45-degree field of view
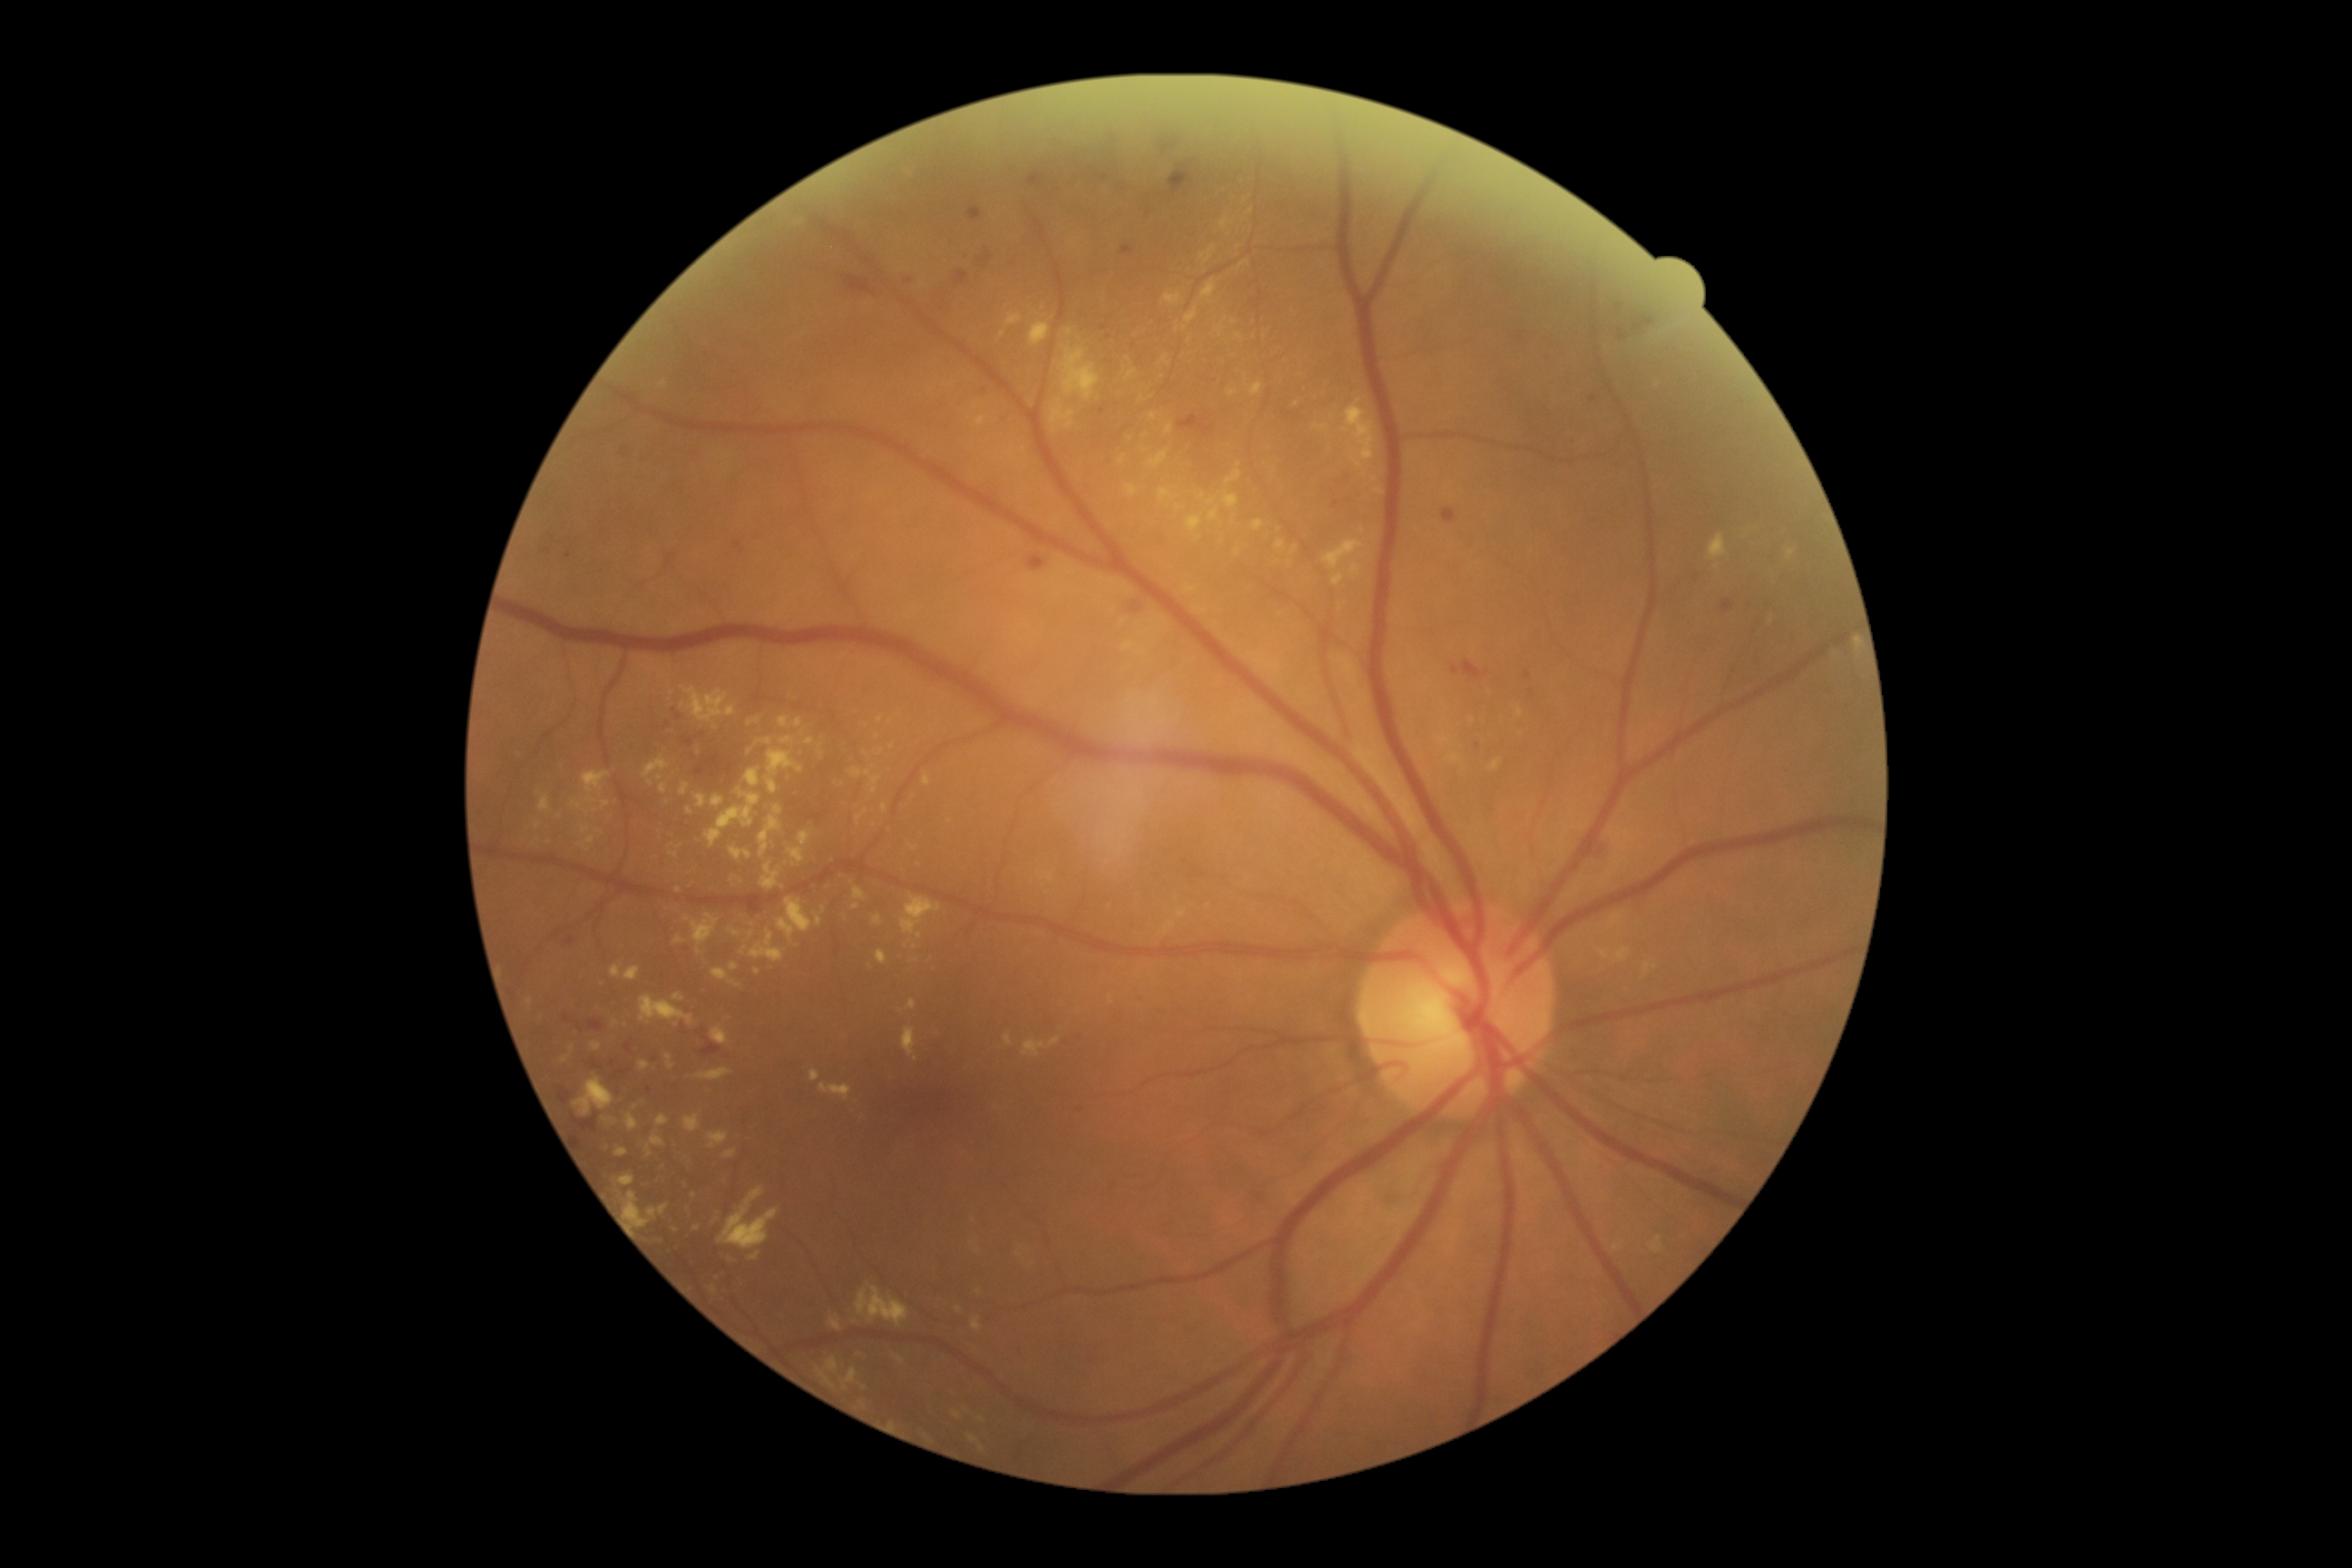
Diabetic retinopathy (DR): grade 2 (moderate NPDR)
A subset of detected lesions:
hard exudates (EXs) (subset): [540, 796, 551, 812] | [614, 1175, 636, 1186] | [774, 807, 783, 816] | [1061, 348, 1101, 400] | [779, 736, 796, 745] | [602, 801, 611, 808] | [1349, 564, 1362, 580] | [1050, 400, 1075, 435] | [707, 1132, 729, 1150] | [1128, 369, 1139, 380] | [908, 999, 917, 1010]
Small EXs approximately at [1351, 350] | [676, 1025] | [1011, 455] | [901, 1012] | [855, 906] | [758, 971] | [1718, 567] | [588, 851]